Wide-field contact fundus photograph of an infant; 130° field of view (Natus RetCam Envision) — 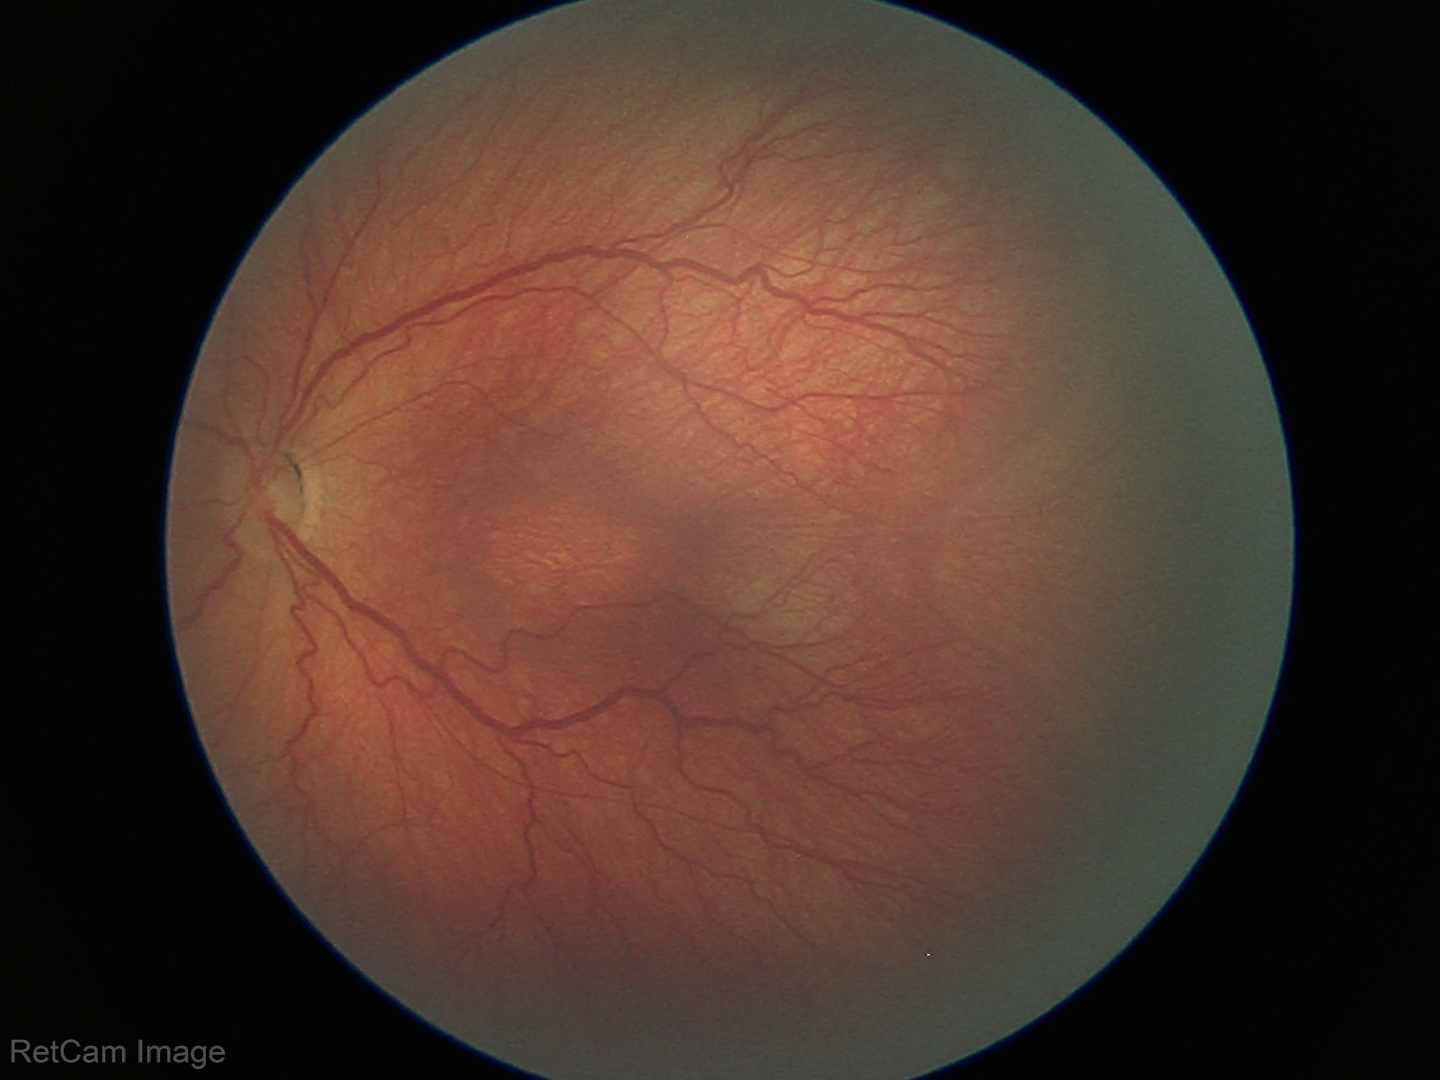 Plus disease: absent, screening diagnosis: retinopathy of prematurity (ROP) stage 3.